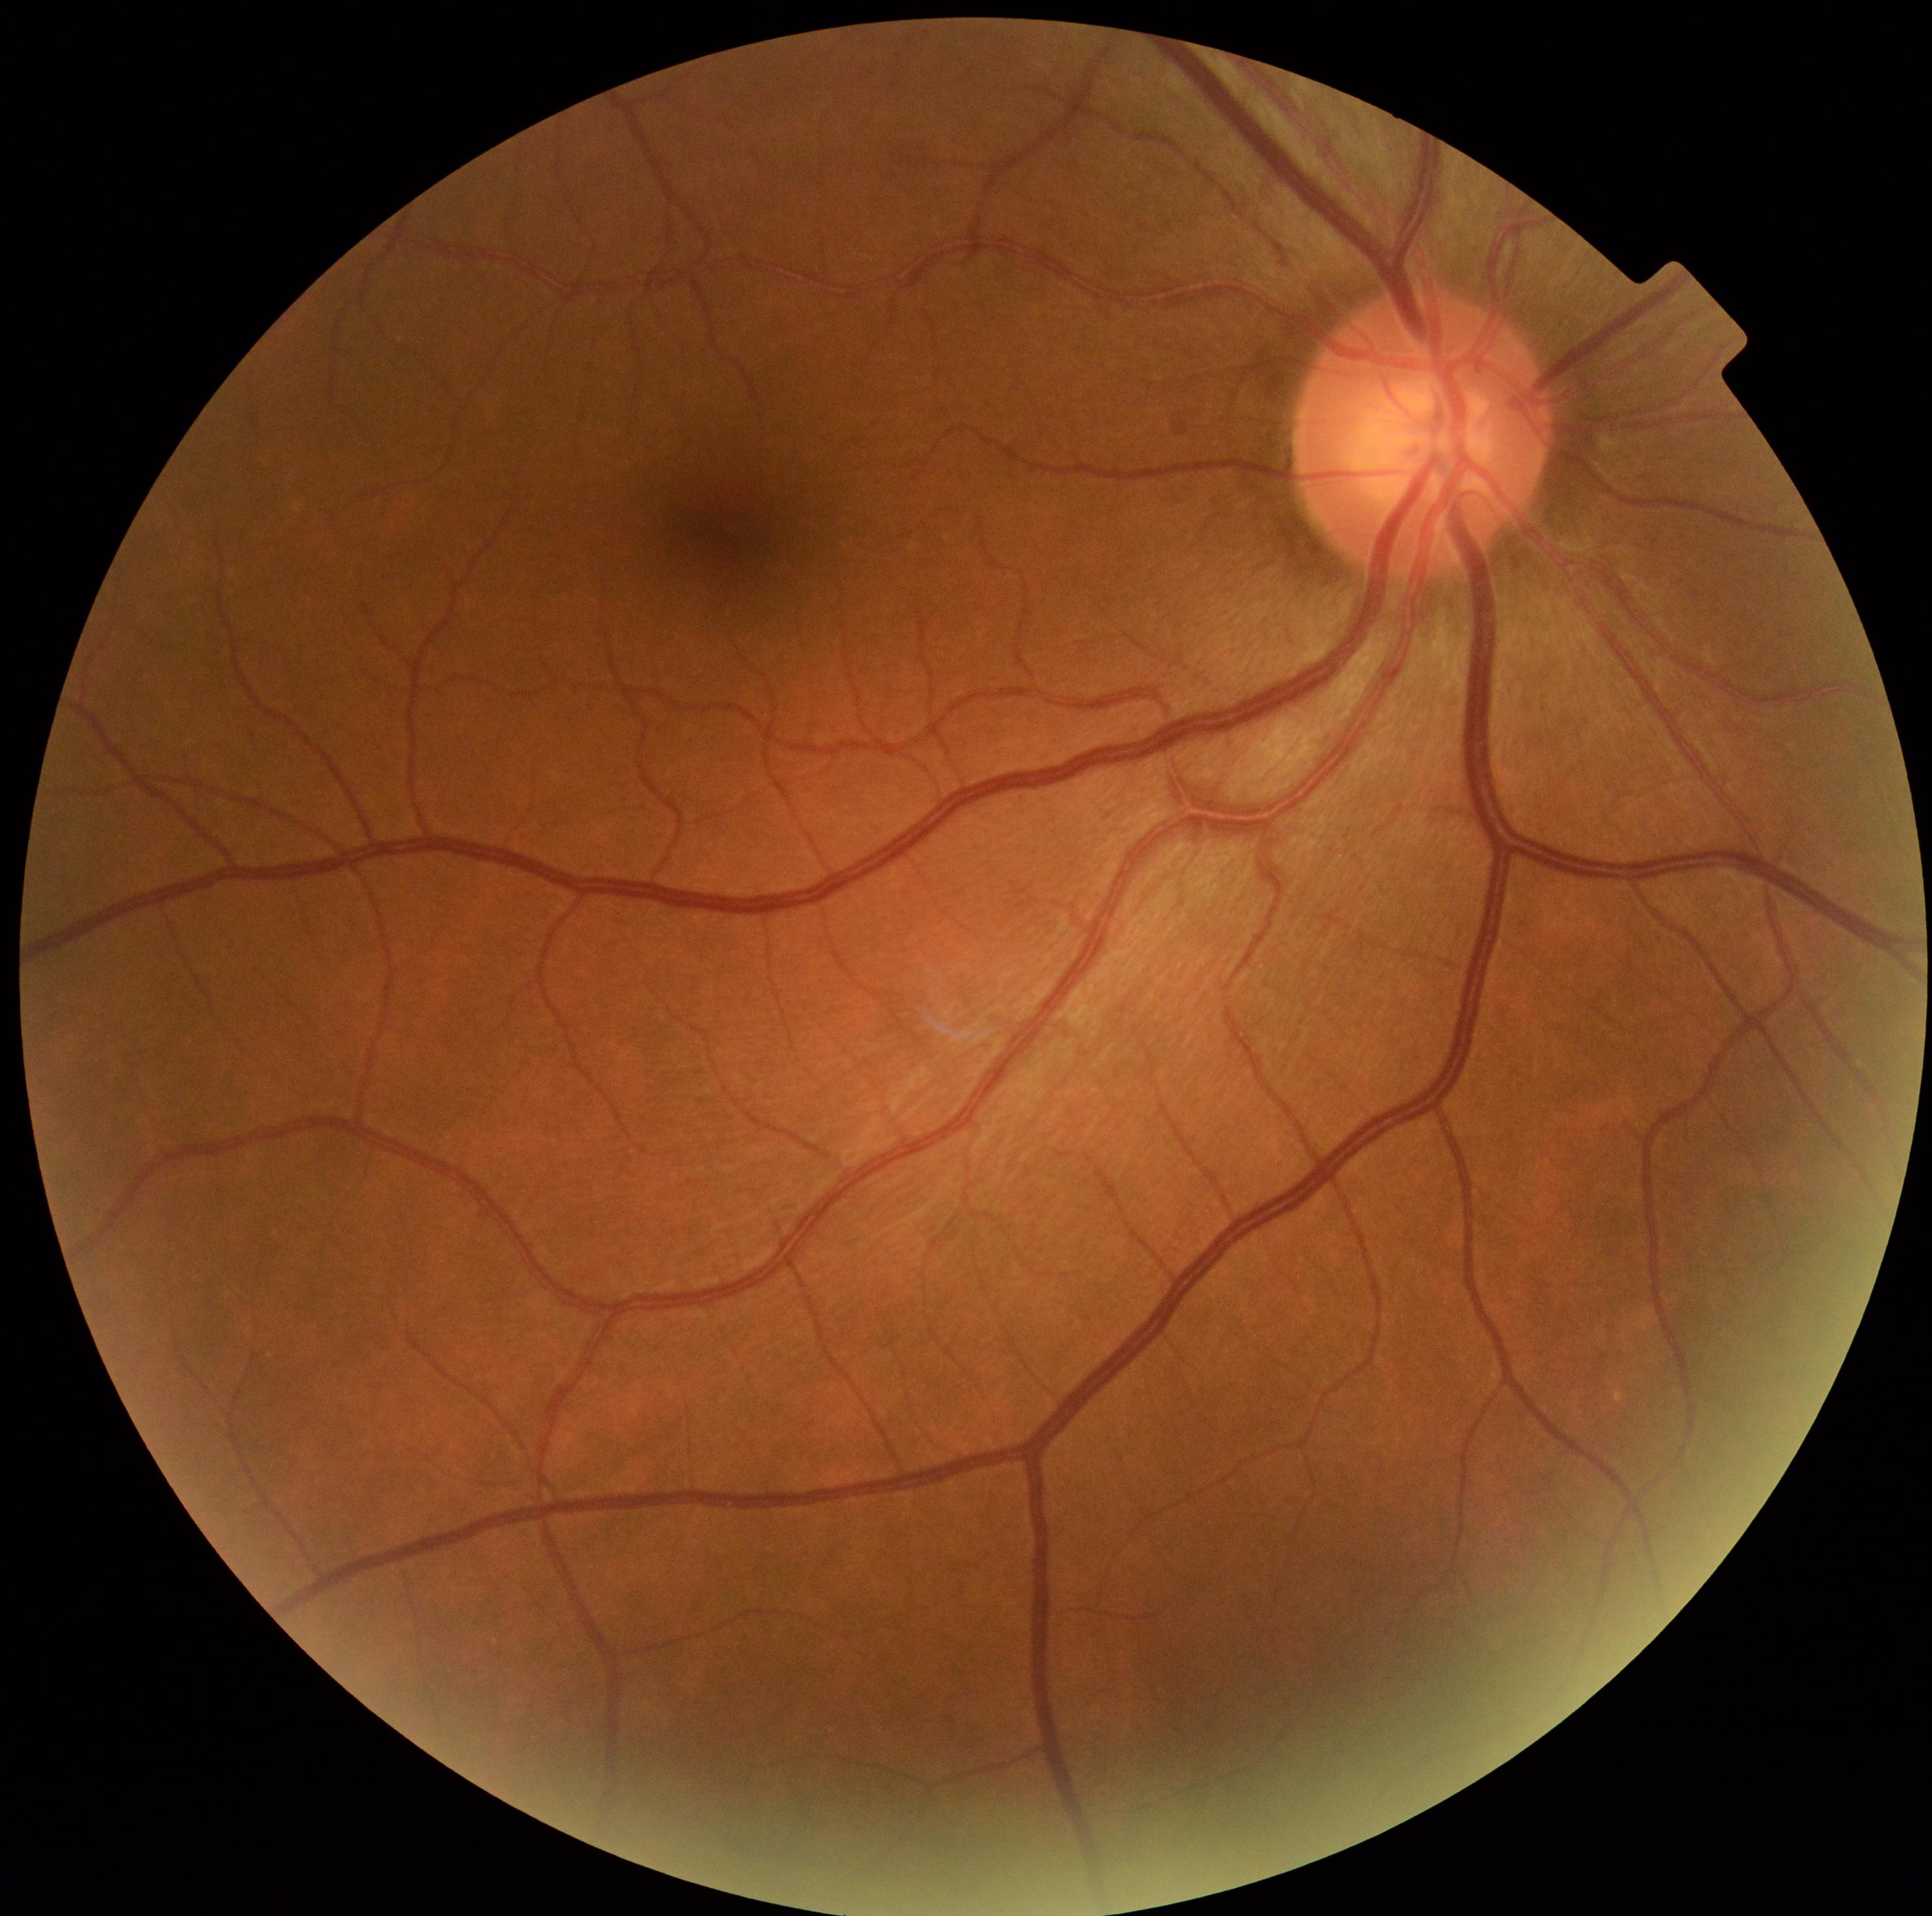
dr_grade: 0 (no apparent retinopathy)